Wide-field fundus photograph of an infant. Camera: Clarity RetCam 3 (130° FOV) — 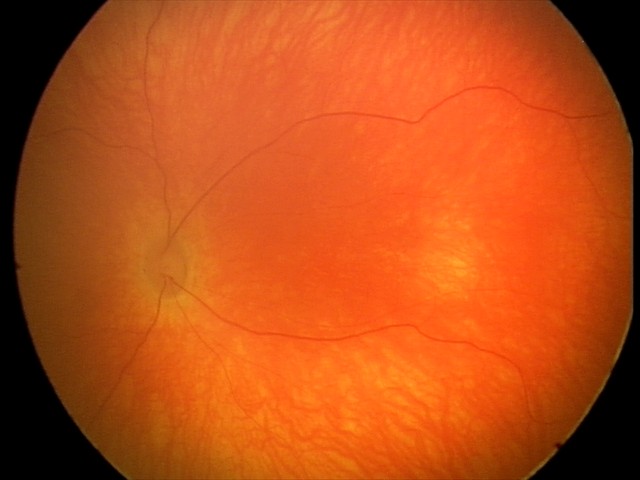 Screening examination with no abnormal retinal findings.